Color fundus image, image size 2228x1652.
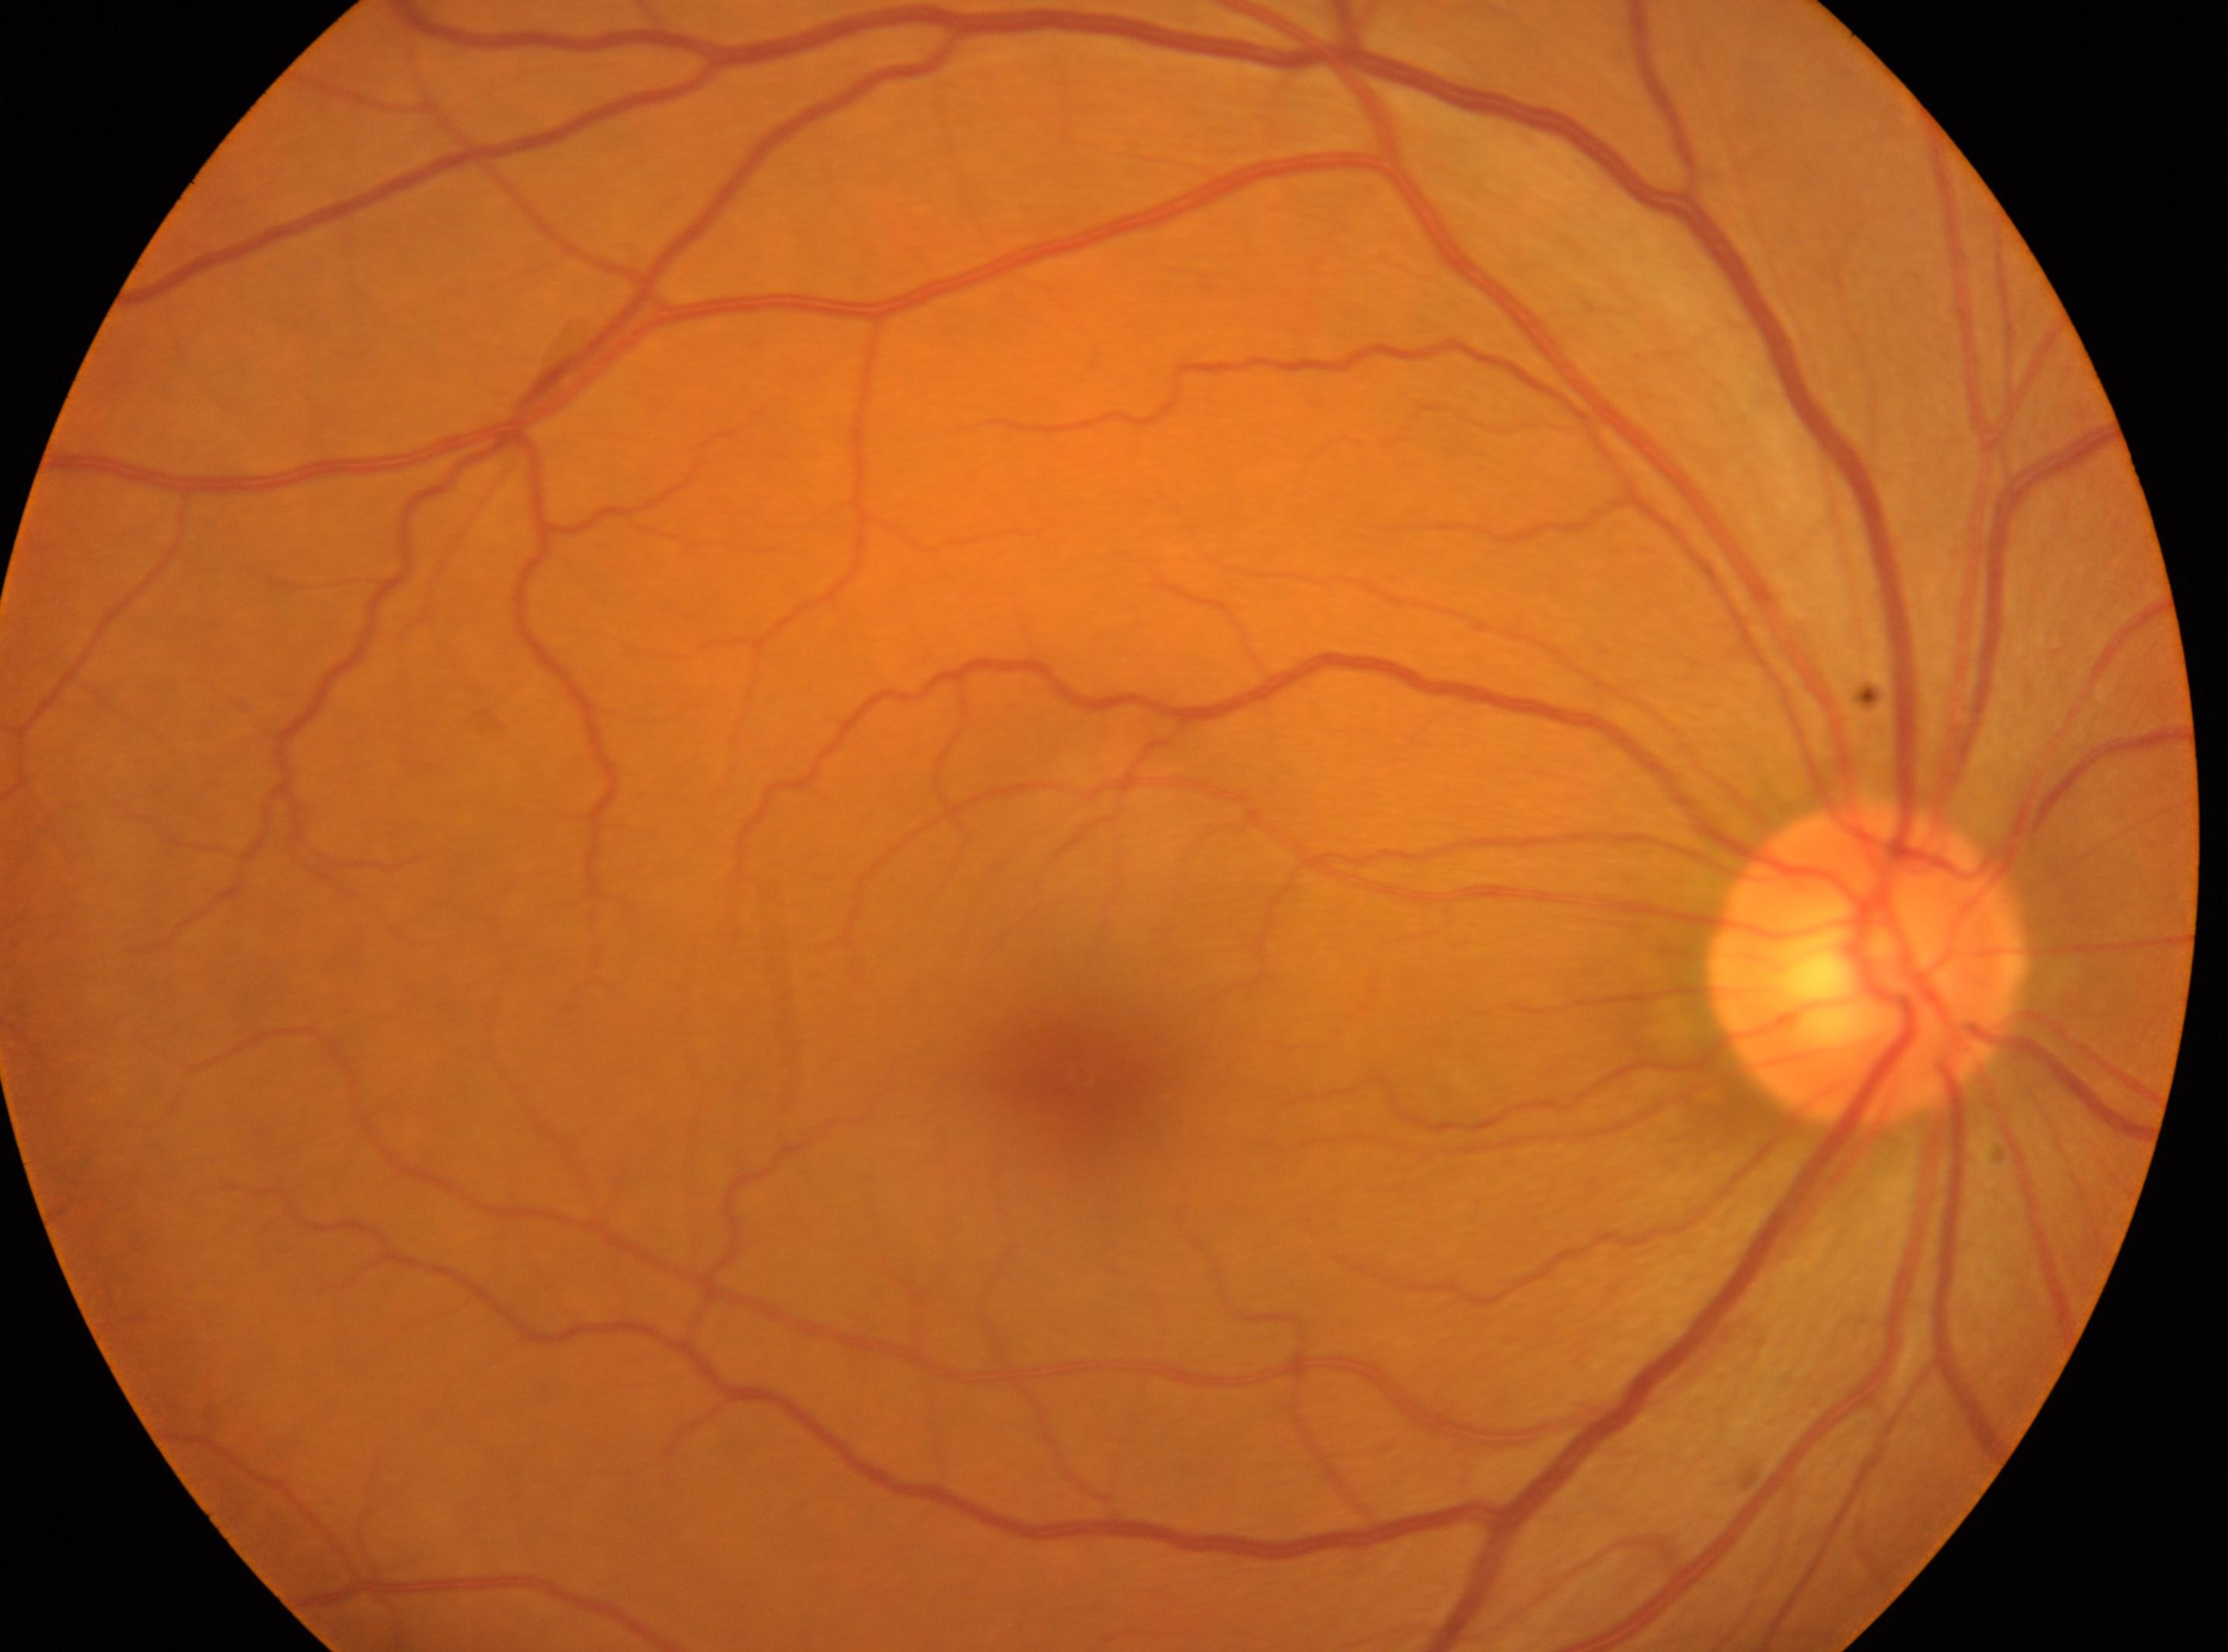
fovea centralis@(1077, 1075) | DR severity@grade 0 (no apparent retinopathy) | oculus dexter | optic disc@(1866, 961).